1380 by 1382 pixels:
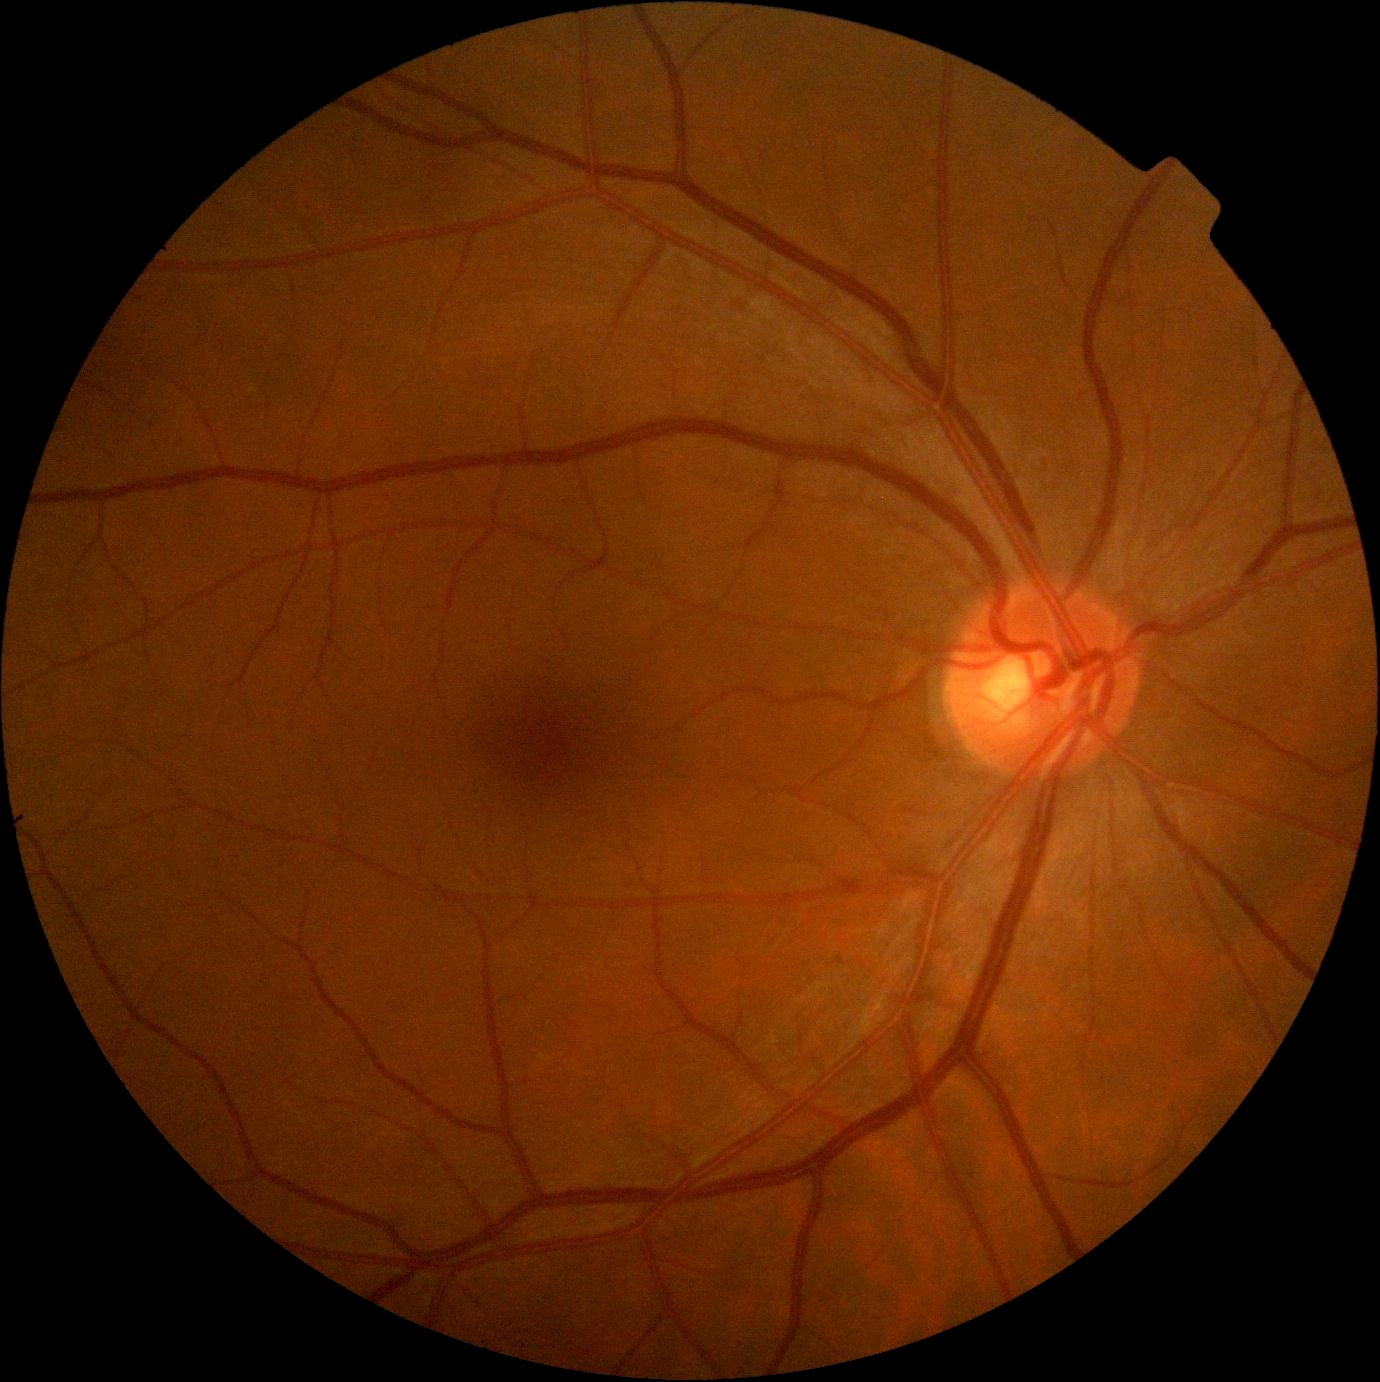 Diabetic retinopathy severity: 0/4.